130° field of view (Clarity RetCam 3). Infant wide-field retinal image:
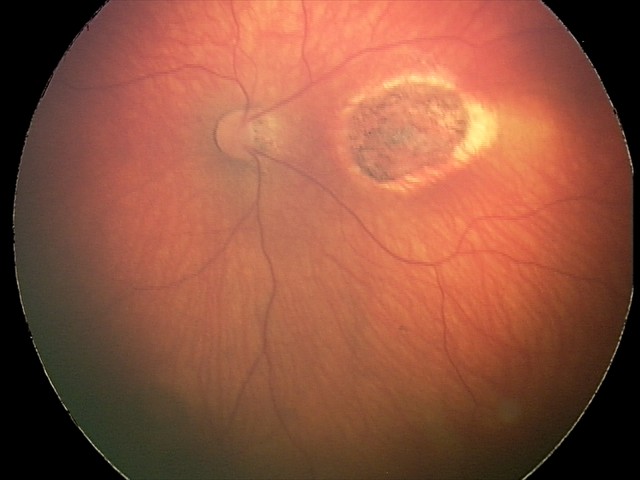
Screening examination consistent with toxoplasmosis chorioretinitis.